Camera: Topcon TRC-NW8 · FOV: 50 degrees.
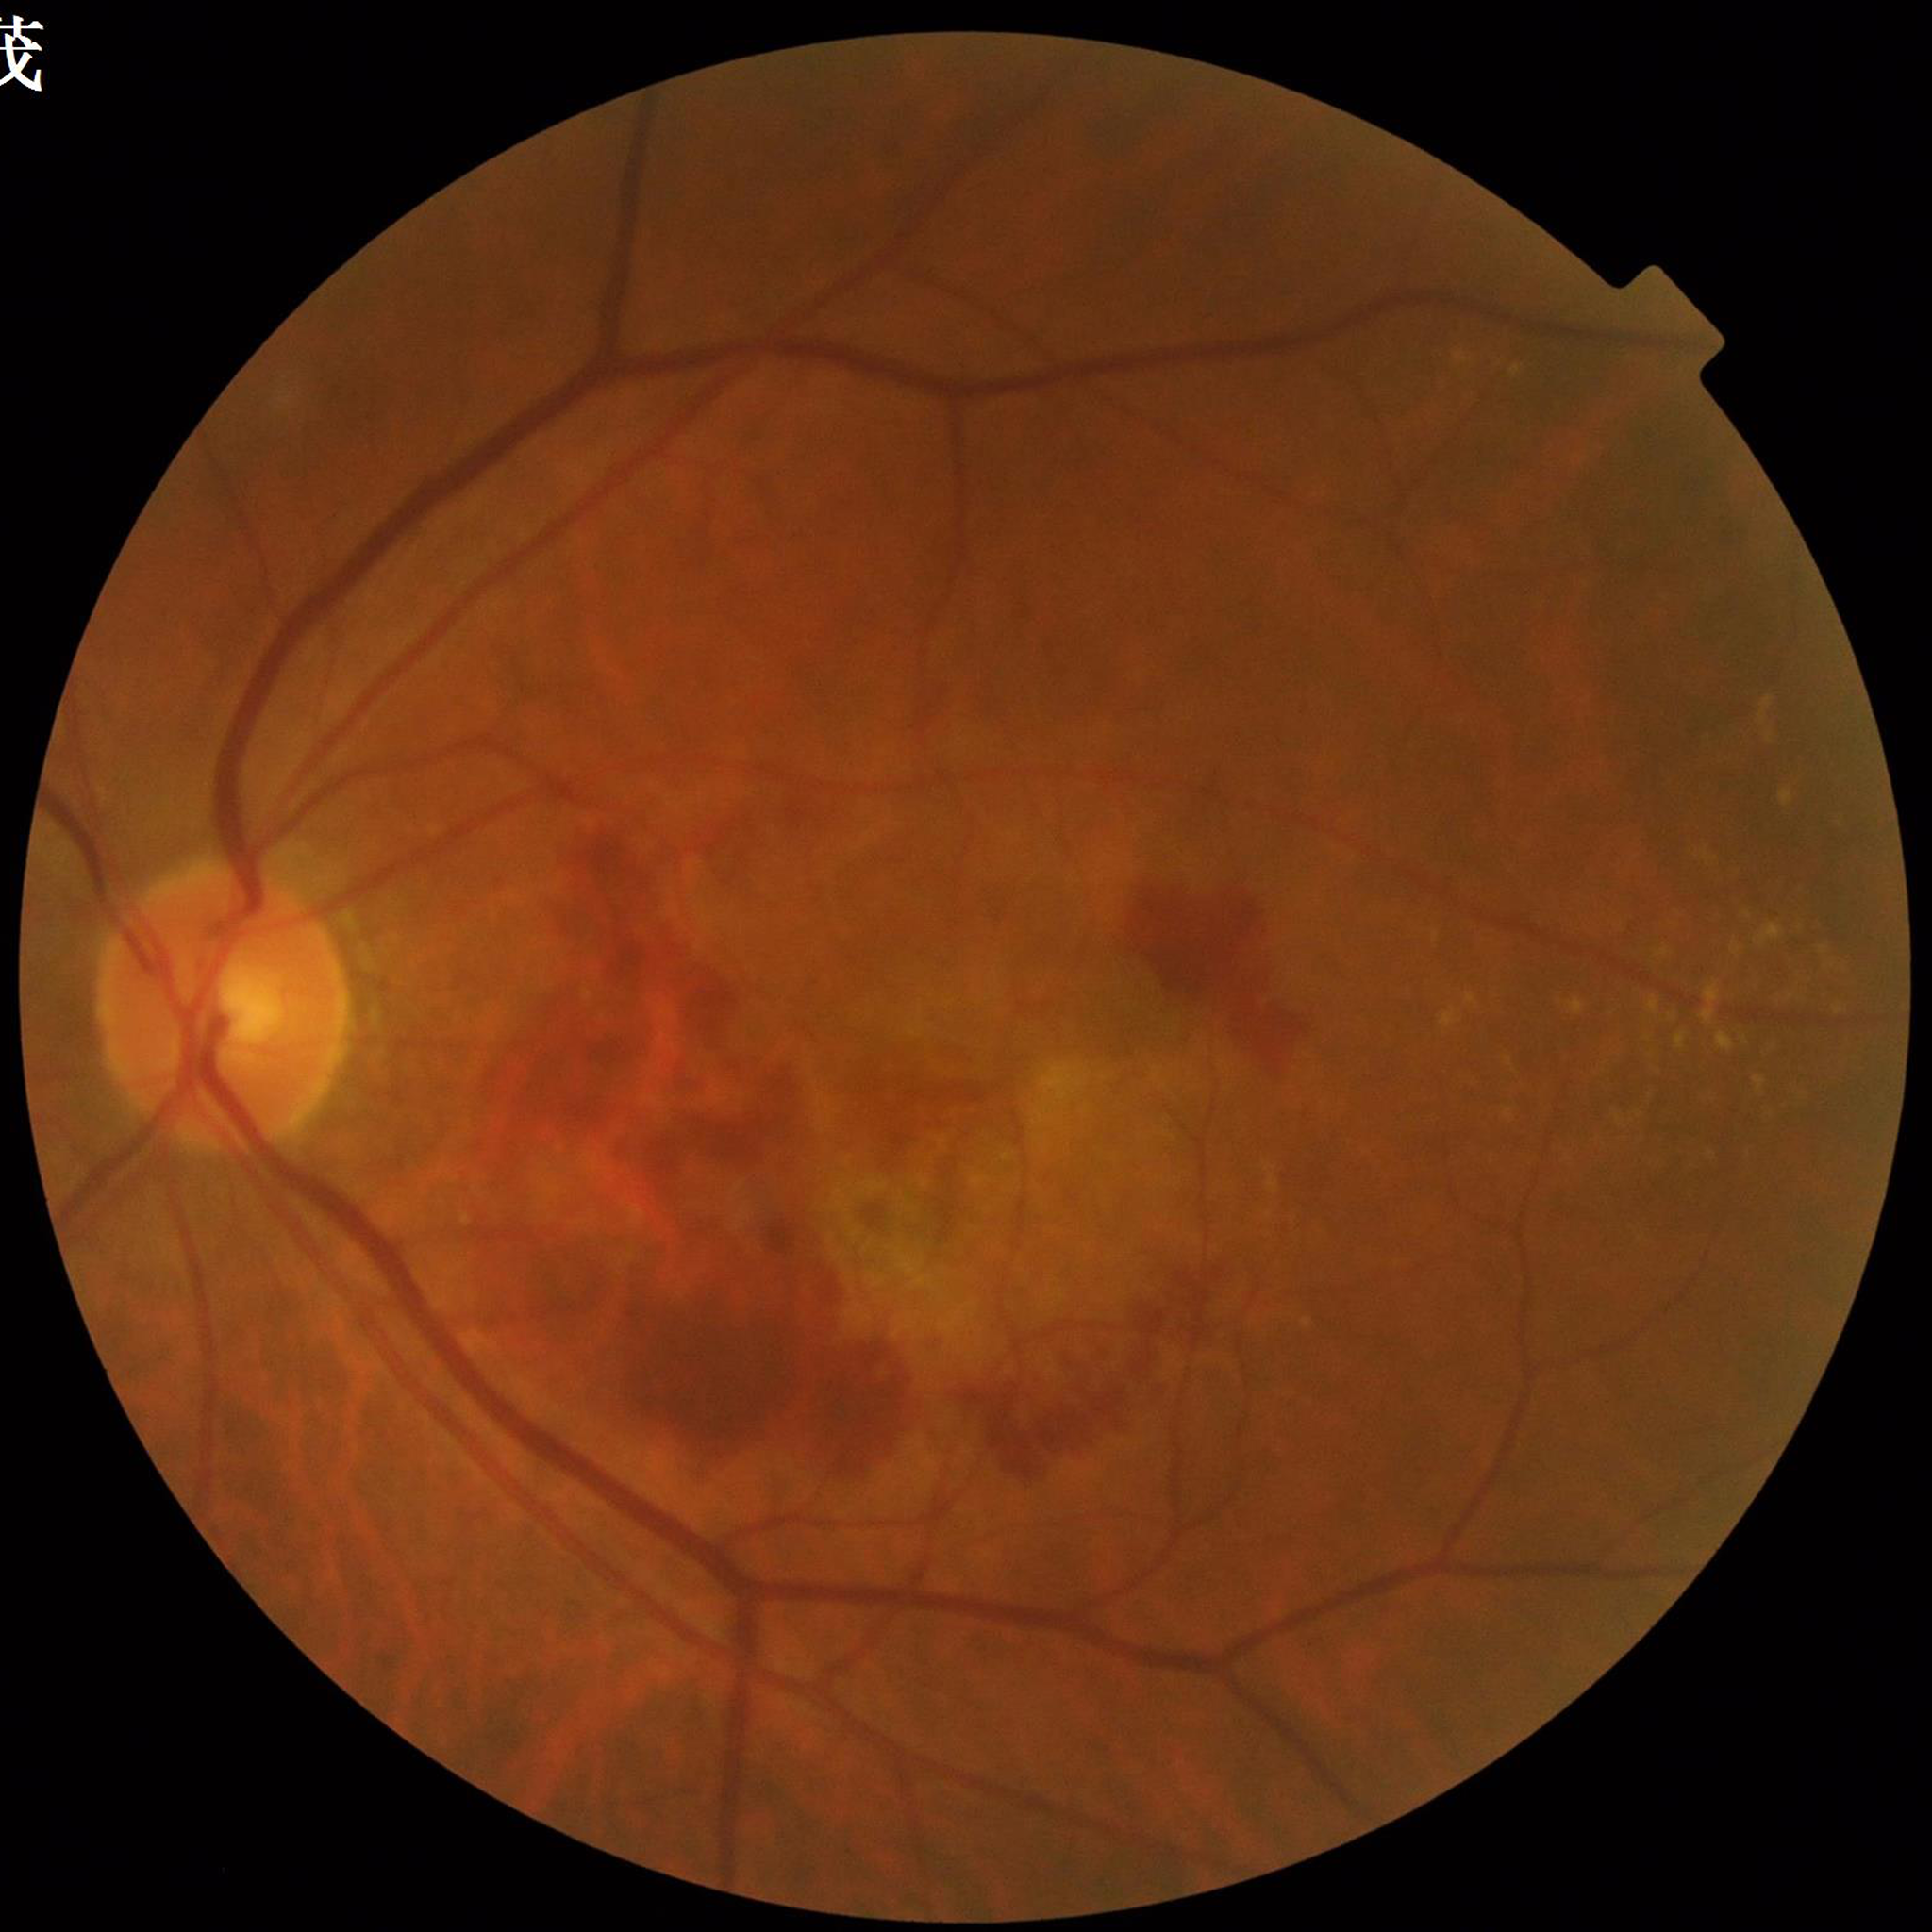
Disease: AMD
Quality assessment: satisfactory